NIDEK AFC-230 · retinal fundus photograph · 45° field of view.
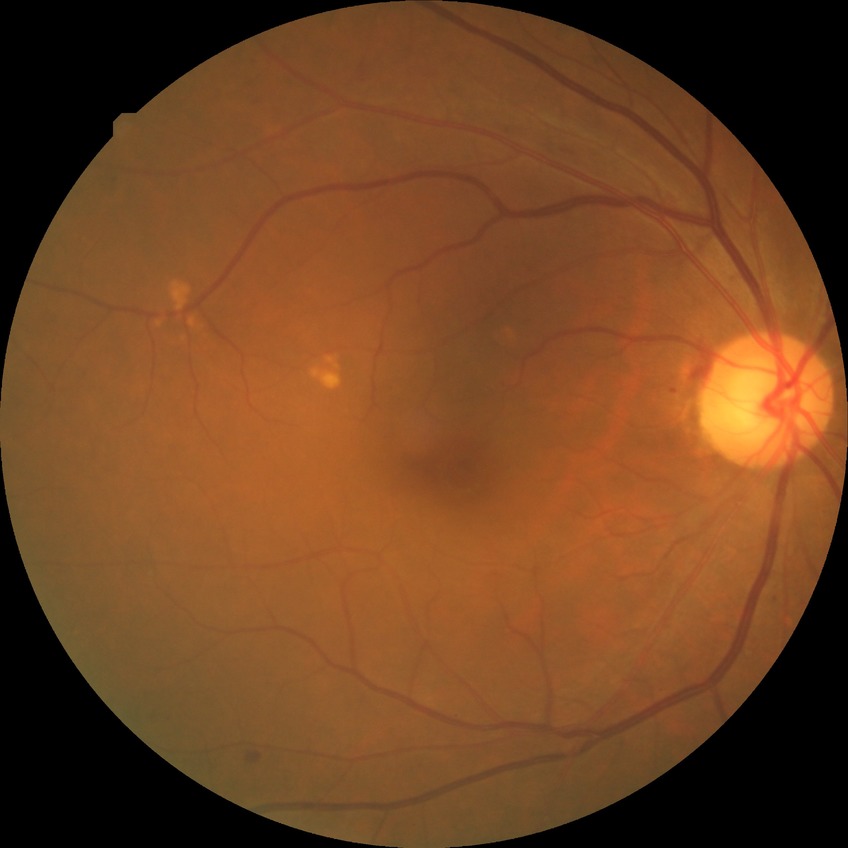
diabetic retinopathy (DR) = simple diabetic retinopathy (SDR).